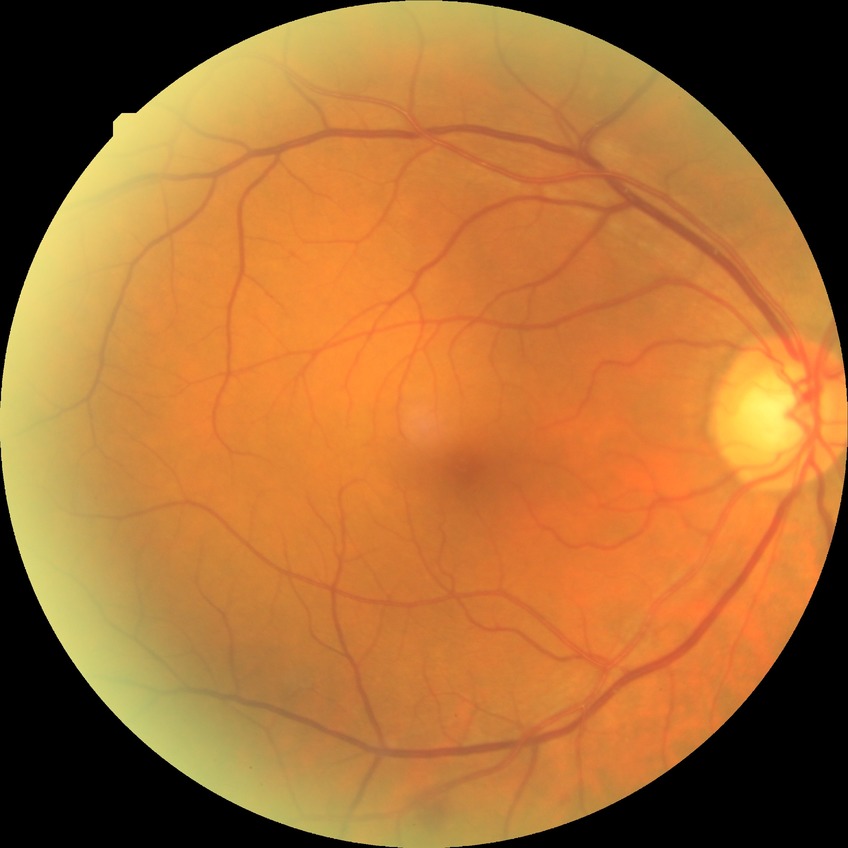

Retinopathy grade: simple diabetic retinopathy.